Color fundus photograph. 848 x 848 pixels. NIDEK AFC-230 fundus camera. DR severity per modified Davis staging
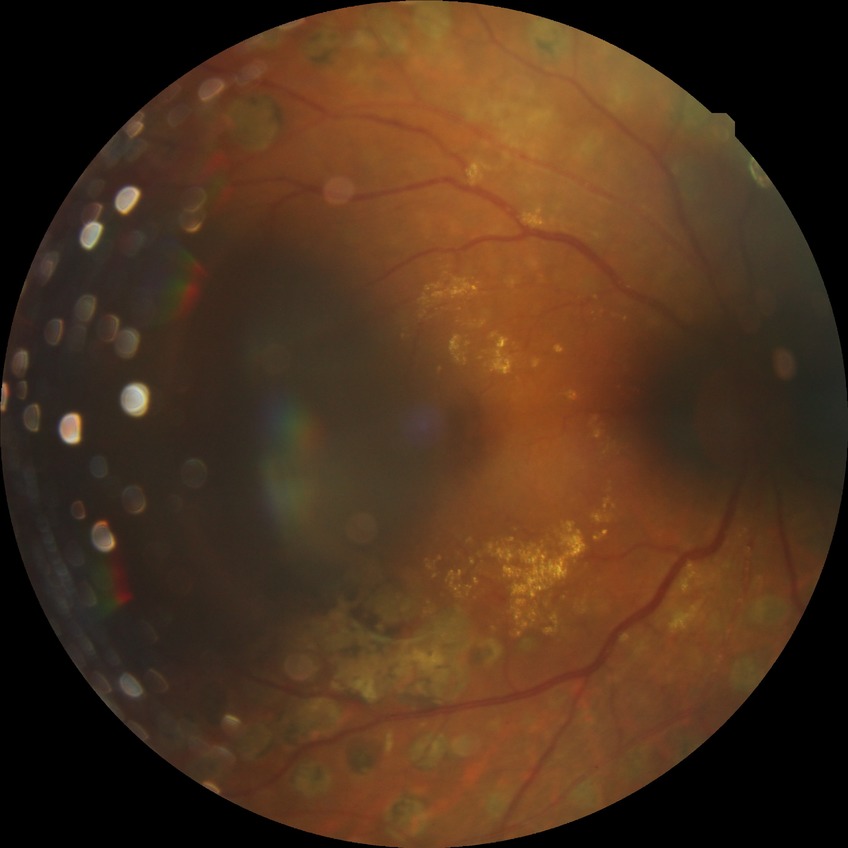 davis_grade: proliferative diabetic retinopathy (PDR)